FOV: 45 degrees: 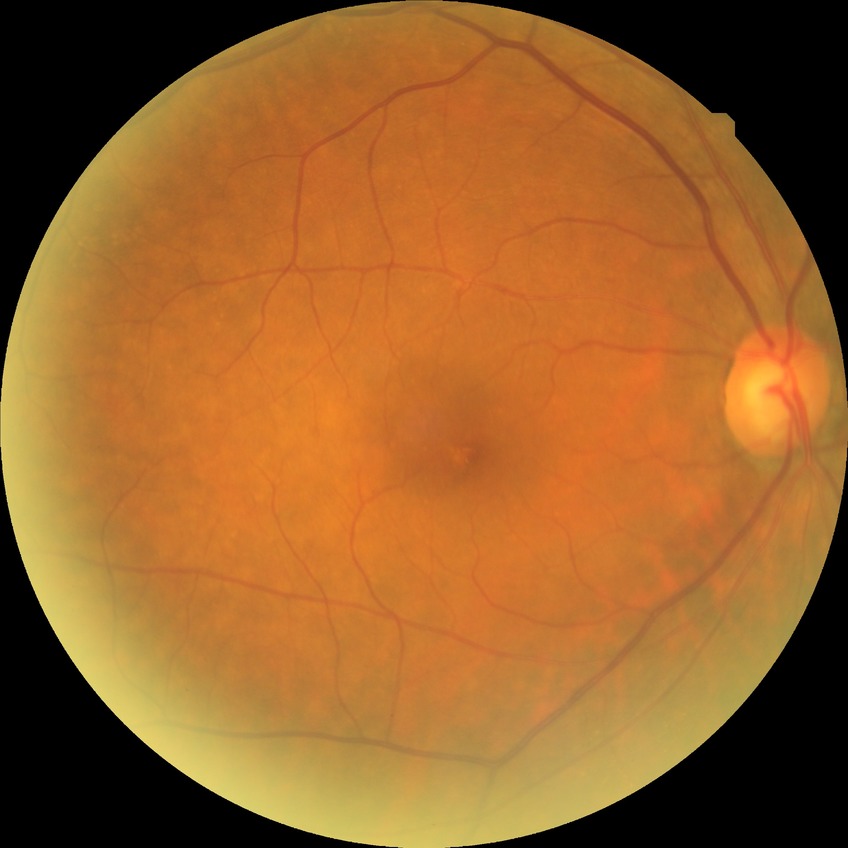
Modified Davis grading: simple diabetic retinopathy.